Optic disc region of a color fundus photo. Camera: Topcon TRC. 35° FOV before cropping — 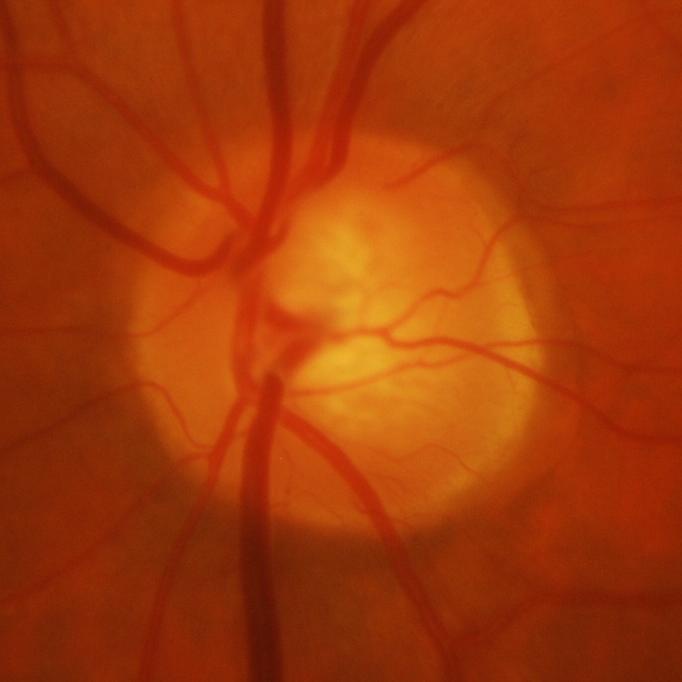 Glaucomatous optic neuropathy is present.
Evidence of glaucoma.